Image size 2212x1659 — 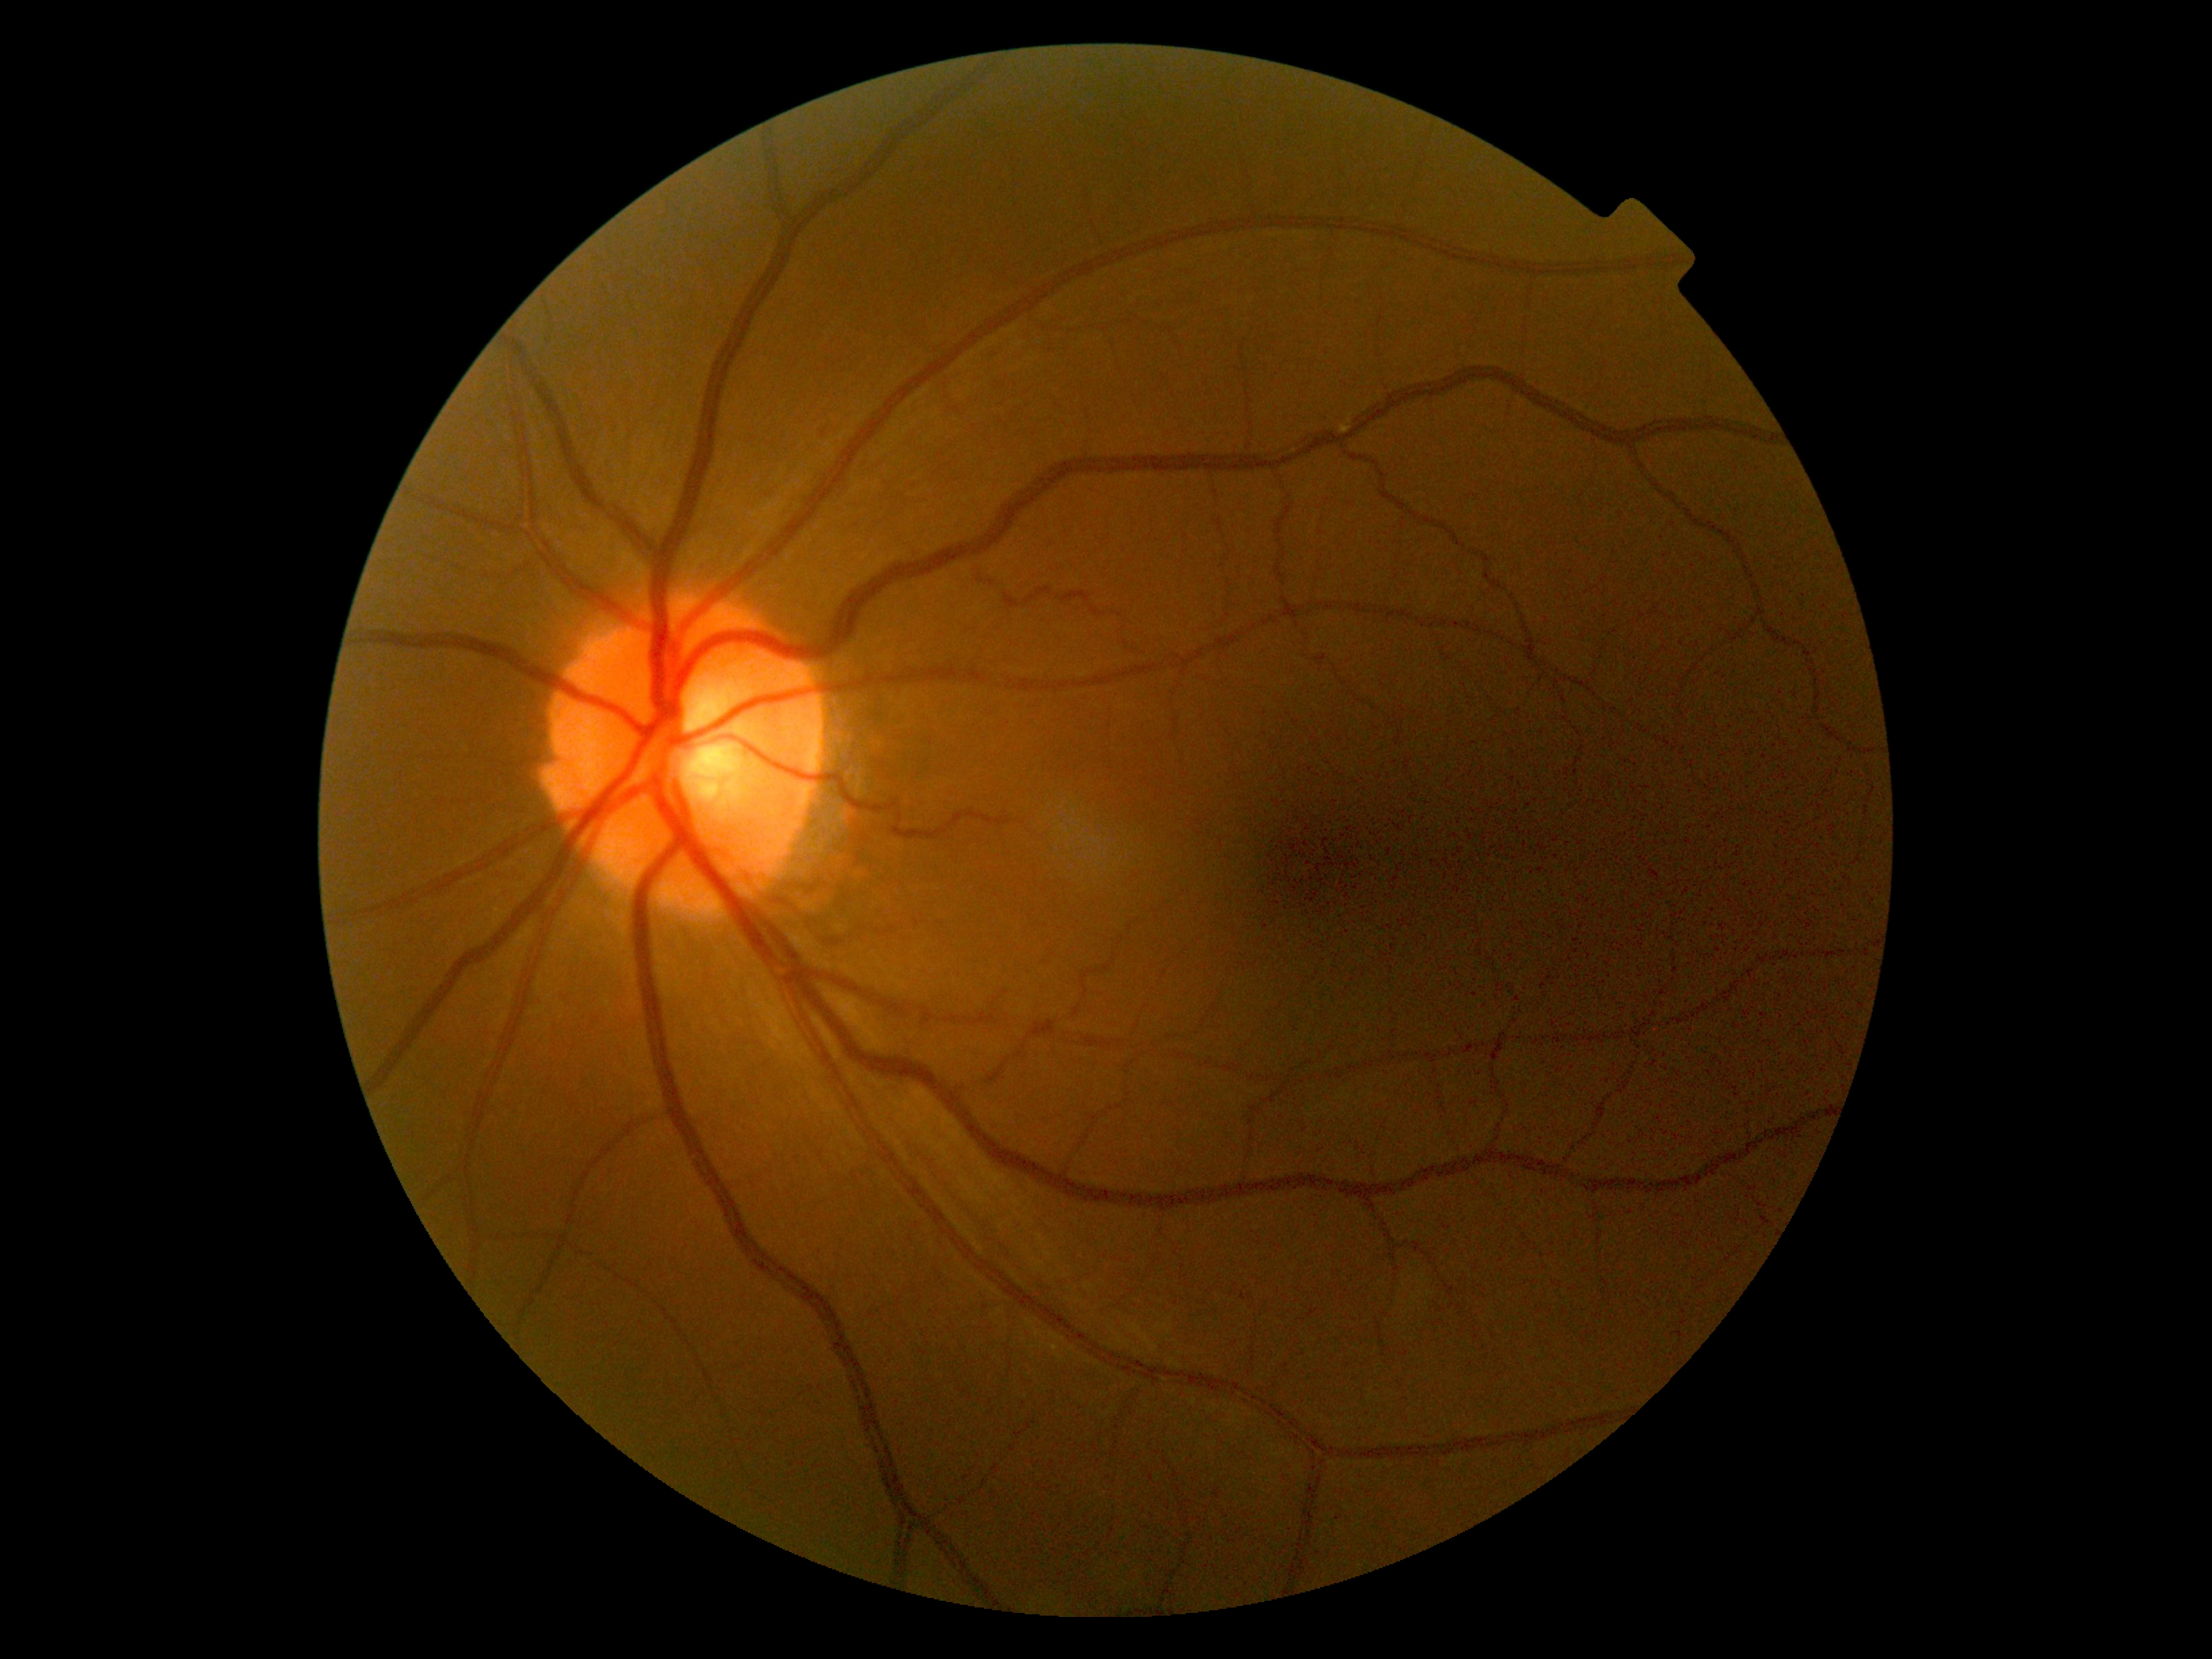
{"dr_grade": "0"}